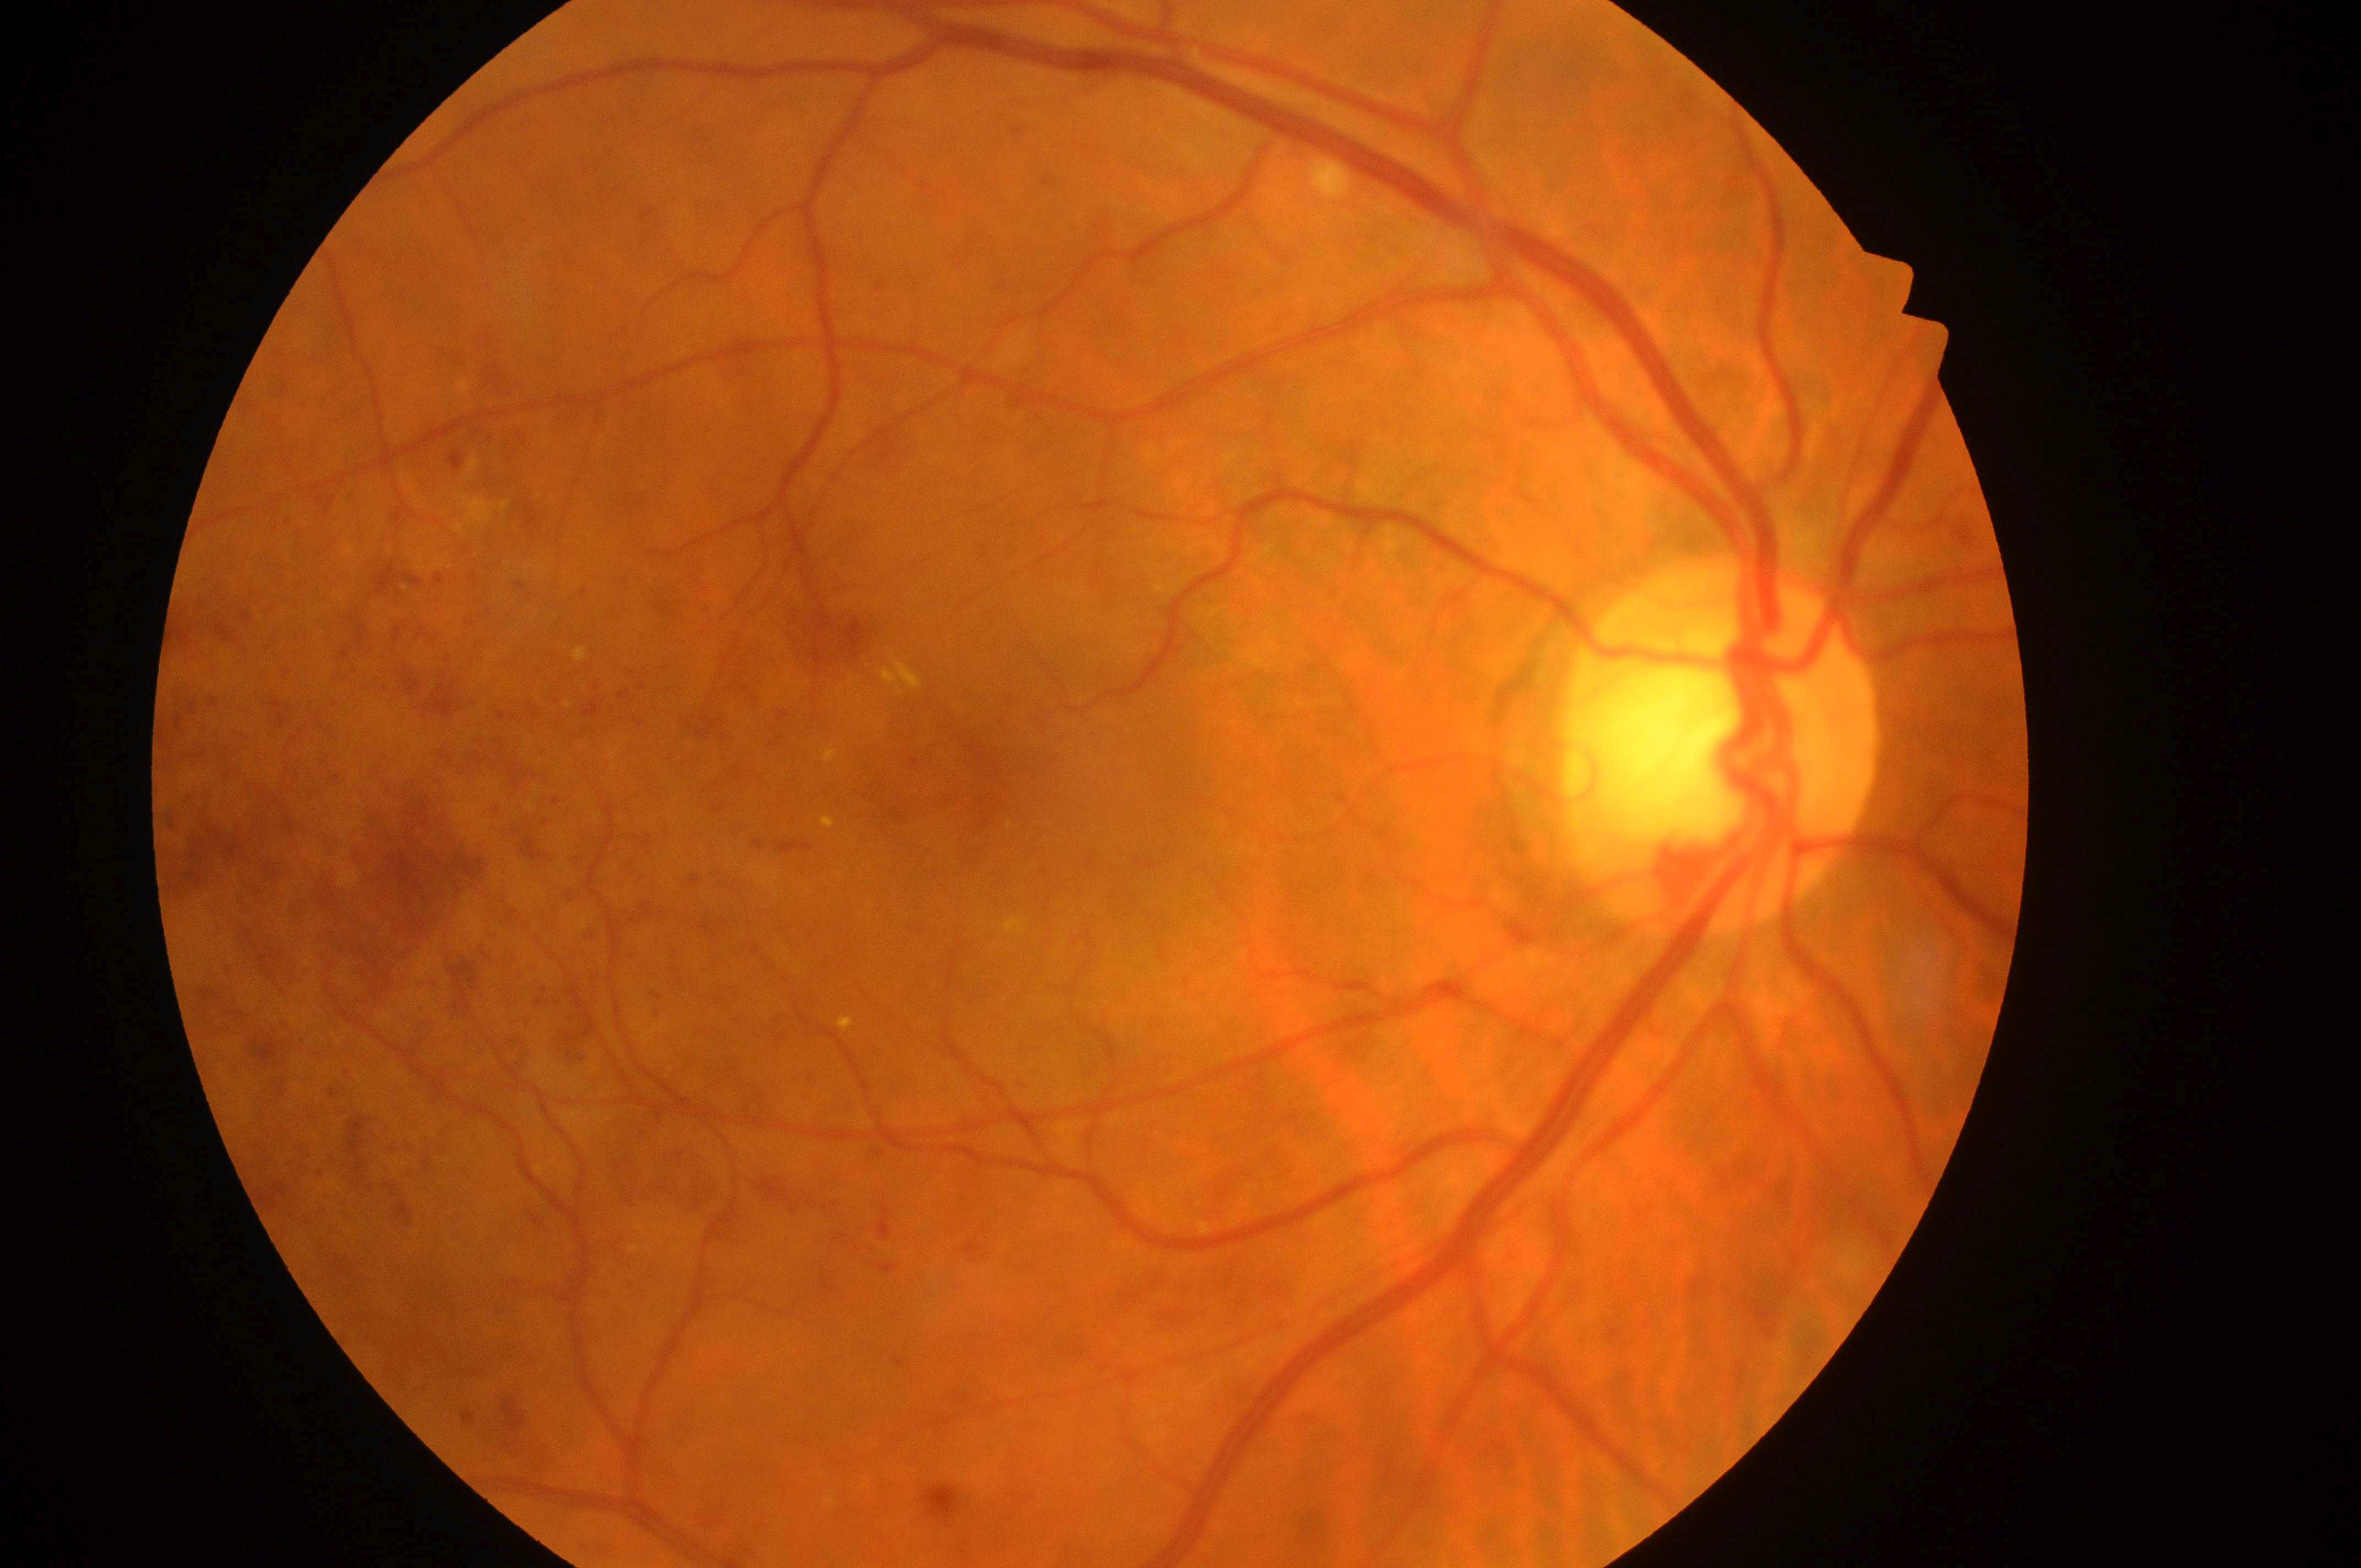
dr_grade: 3
eye: right eye
fovea: [988, 781]
dme_grade: 2
optic_disc: [1714, 754]